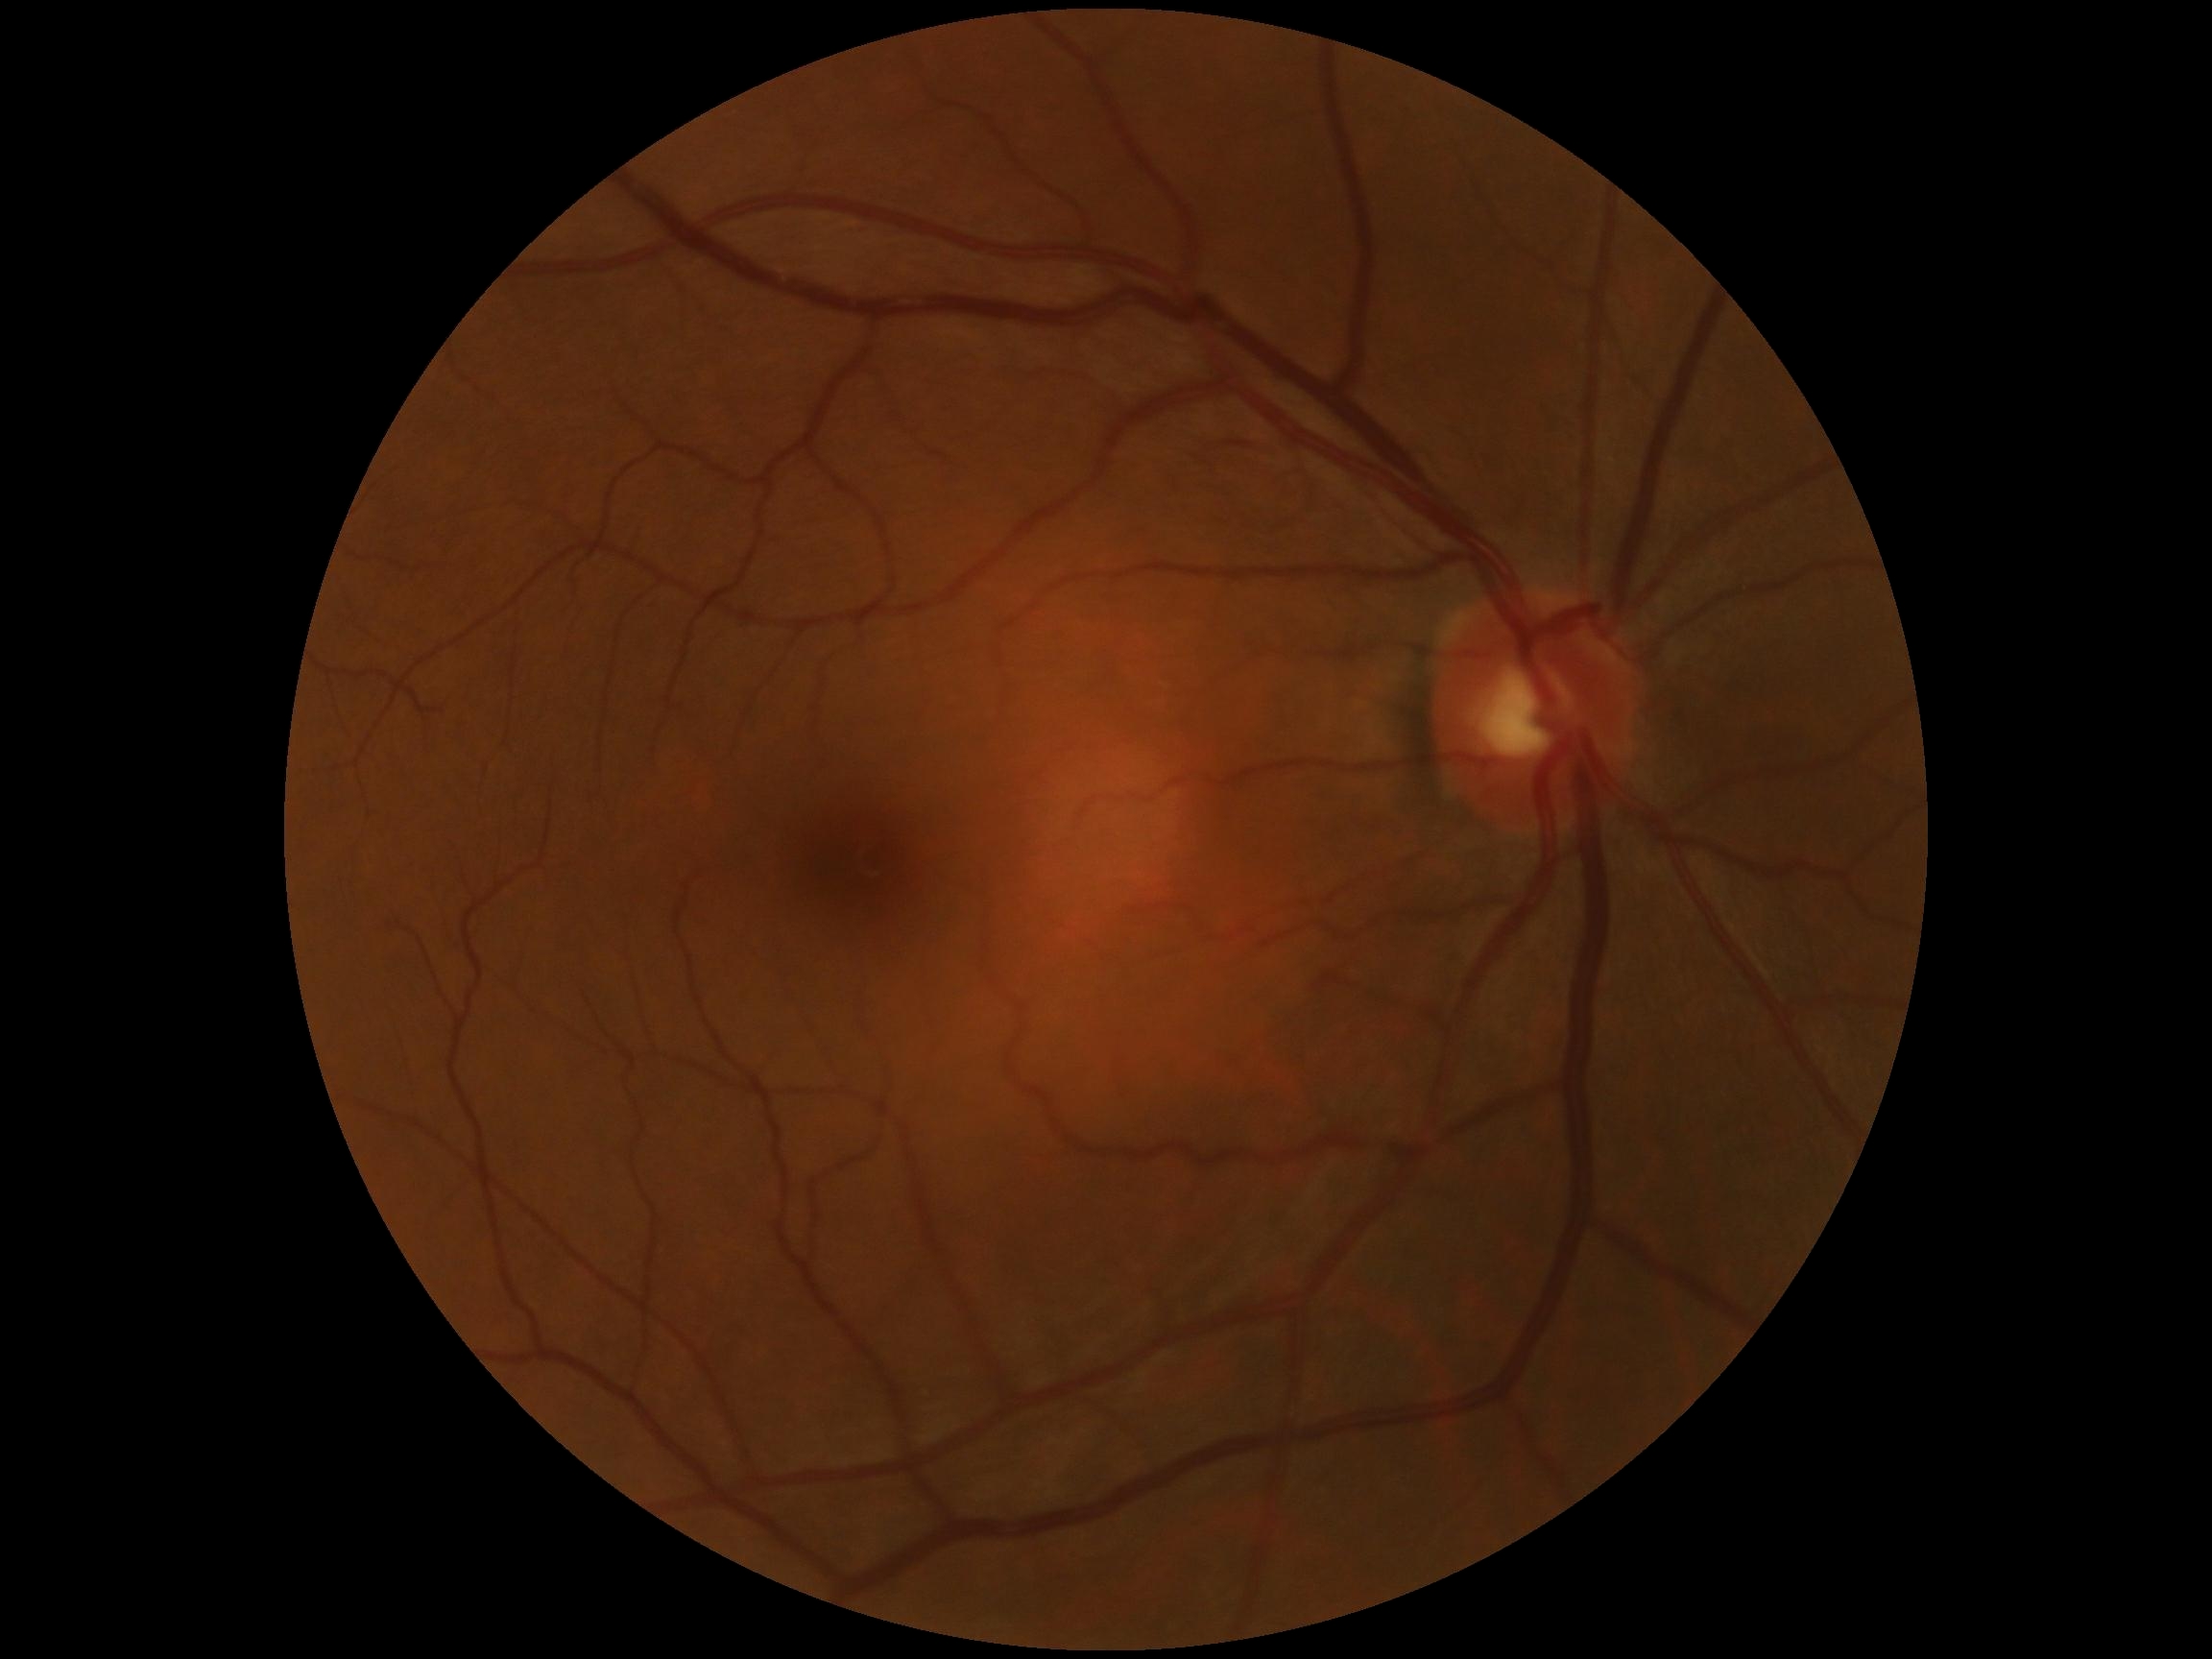
DR stage: grade 0 (no apparent retinopathy) — no visible signs of diabetic retinopathy.